Camera: Clarity RetCam 3 (130° FOV); 640x480px; wide-field contact fundus photograph of an infant.
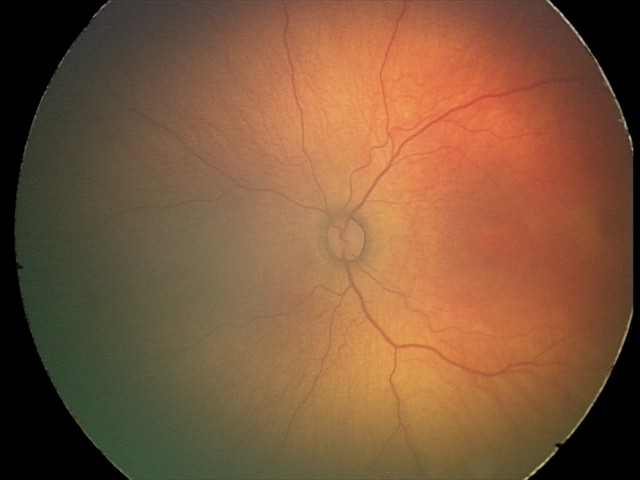

Plus form: absent — posterior pole vessels without abnormal dilation or tortuosity
diagnosis: status post retinopathy of prematurity (ROP)